Captured with the Clarity RetCam 3 (130° field of view) · image size 640x480 · RetCam wide-field infant fundus image — 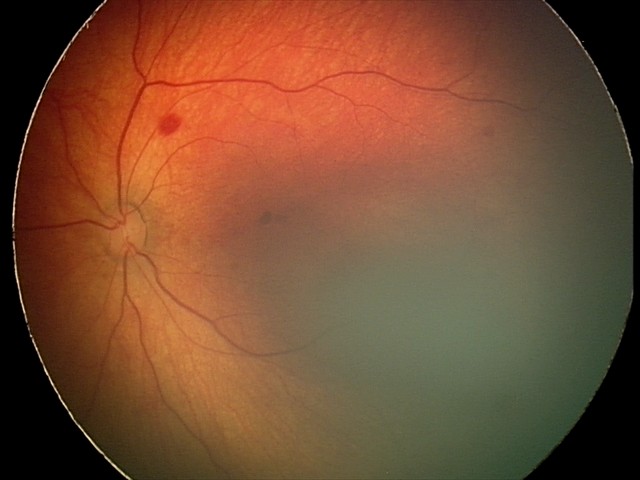

Series diagnosed as retinal hemorrhages.